1920 x 1440 pixels:
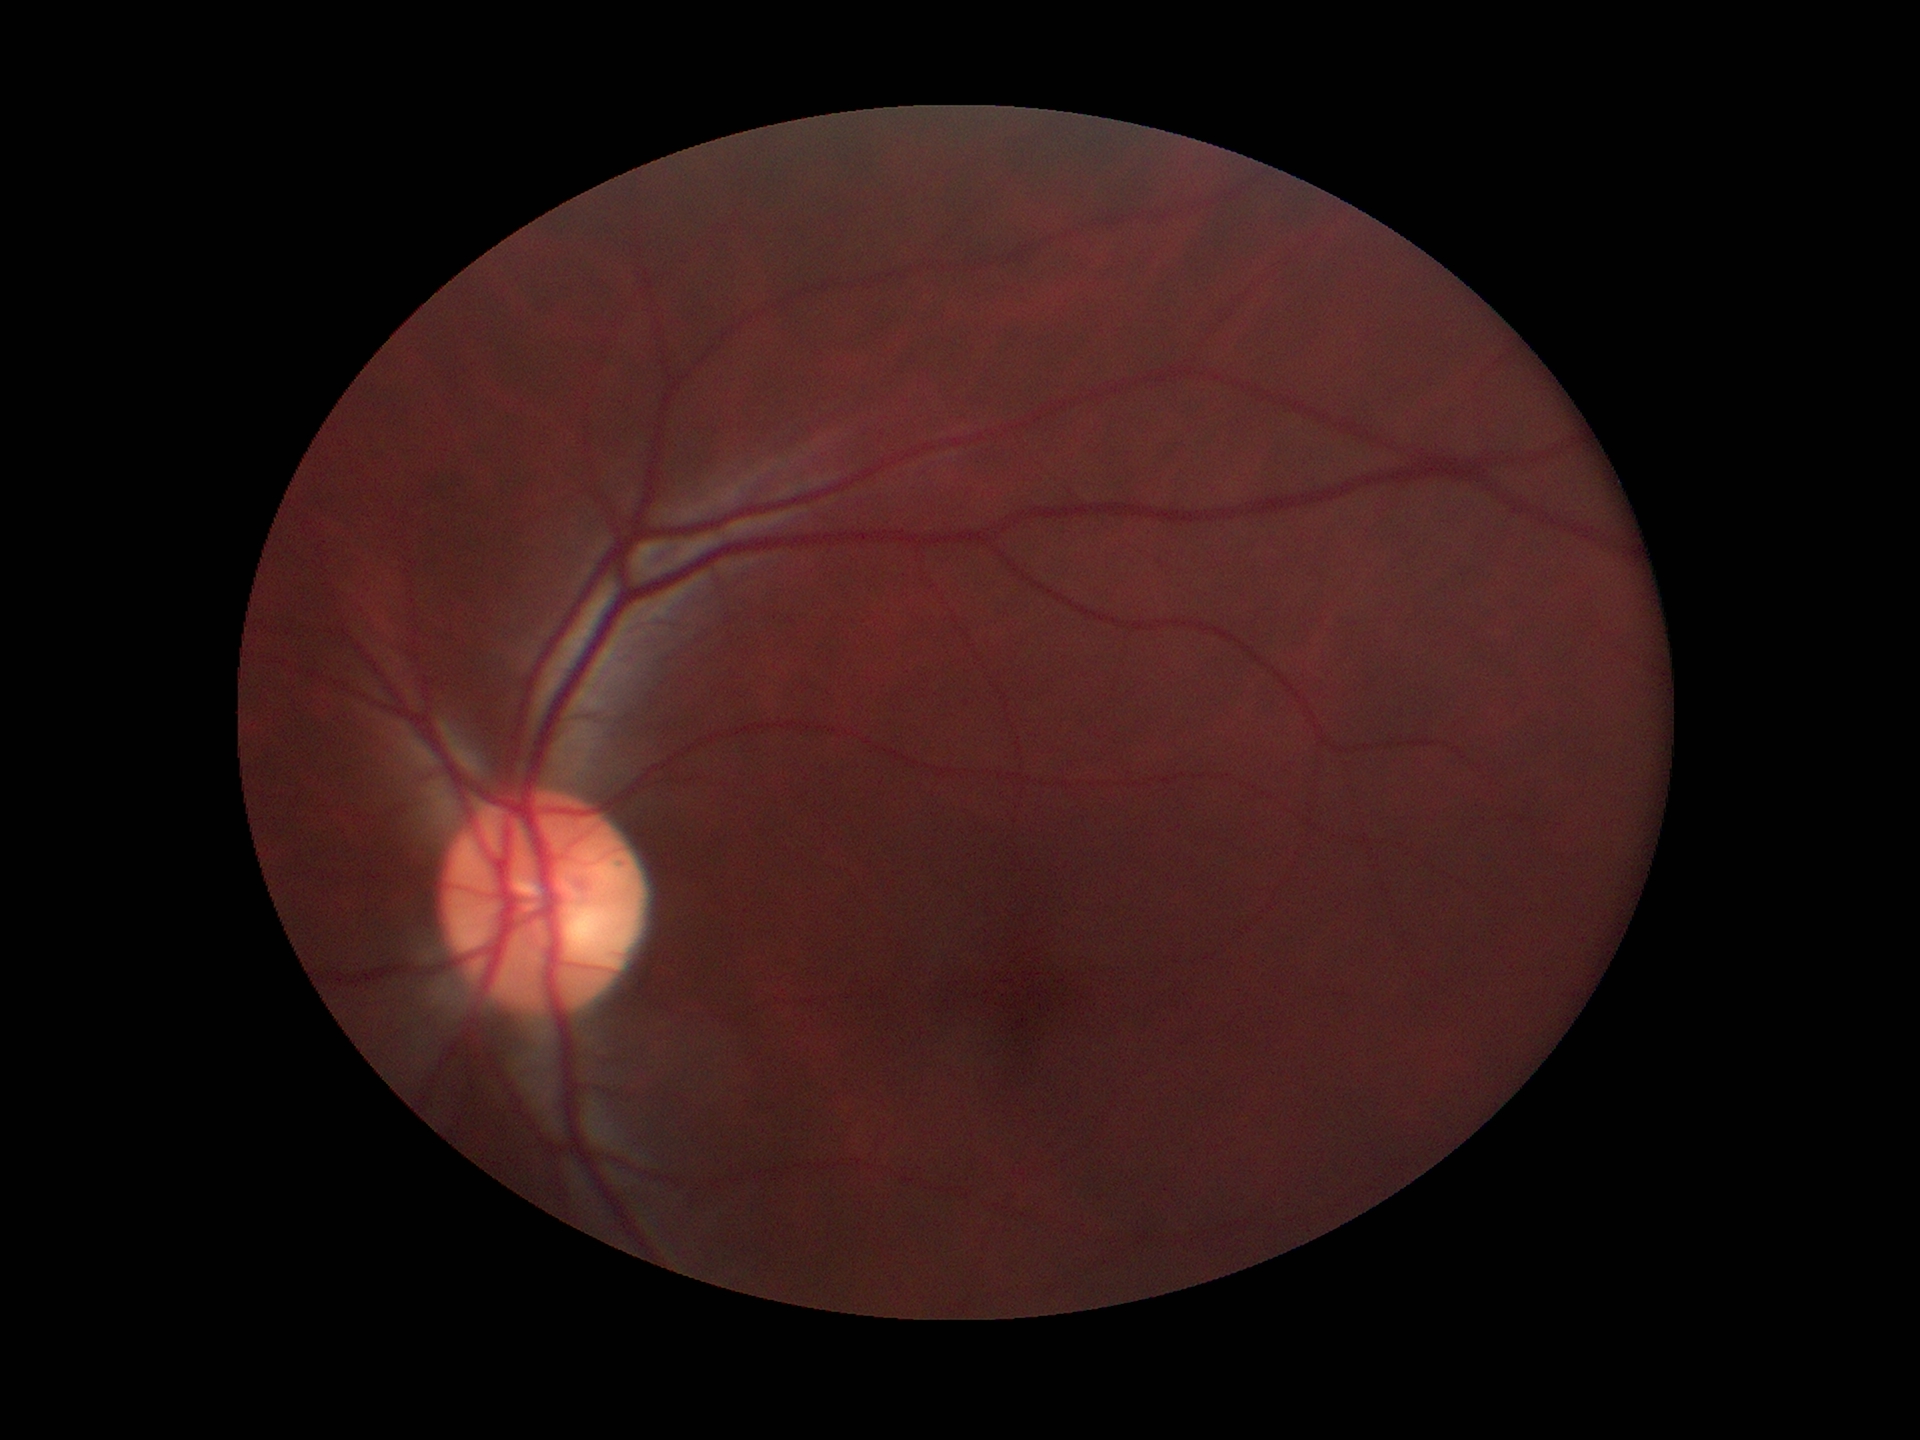 Not suspicious for glaucoma.
VCDR of 0.51.